848 by 848 pixels · nonmydriatic — 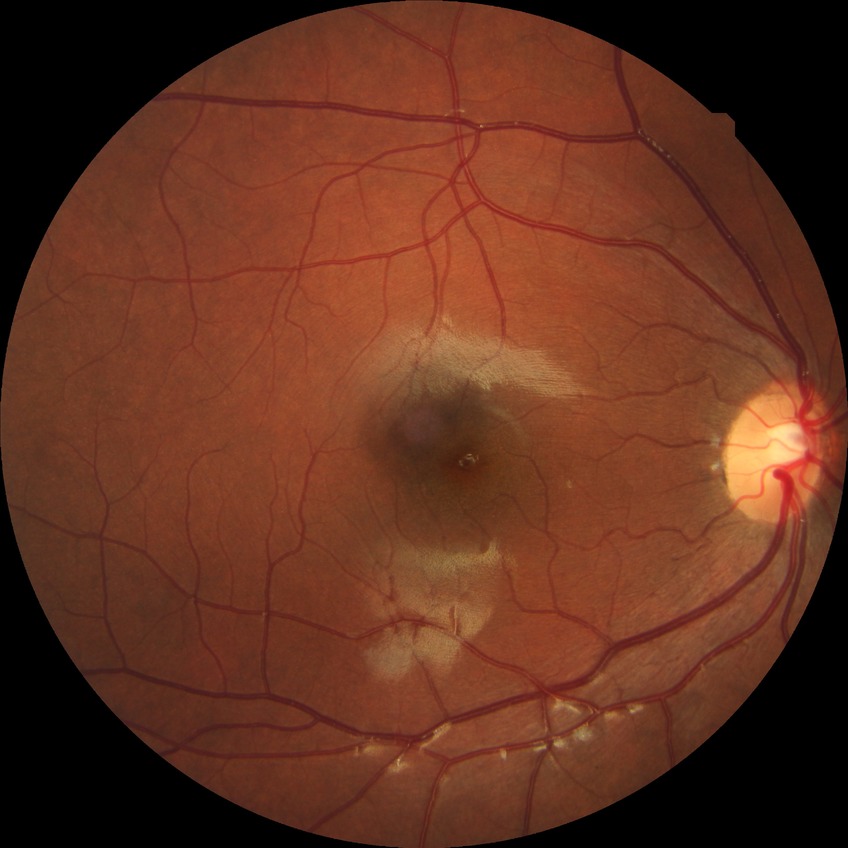 Modified Davis classification is no diabetic retinopathy.